Wide-field fundus photograph from neonatal ROP screening:
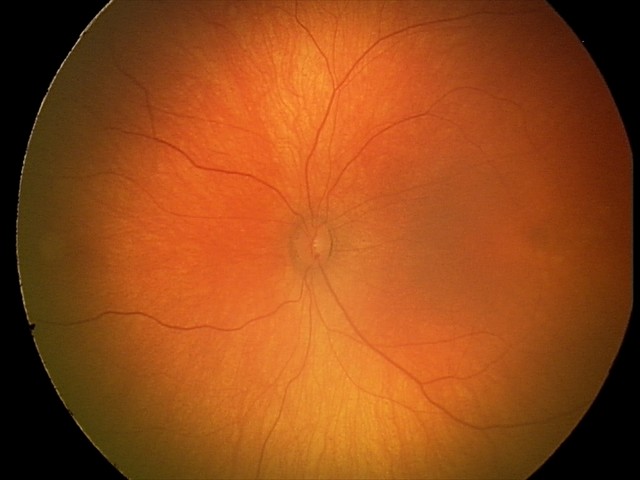
Screening examination with no abnormal retinal findings.